Infant wide-field retinal image; 640x480px
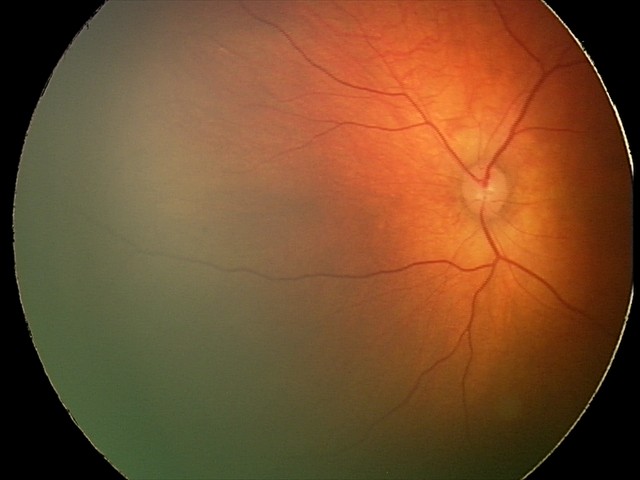 Series diagnosed as retinal hemorrhages.